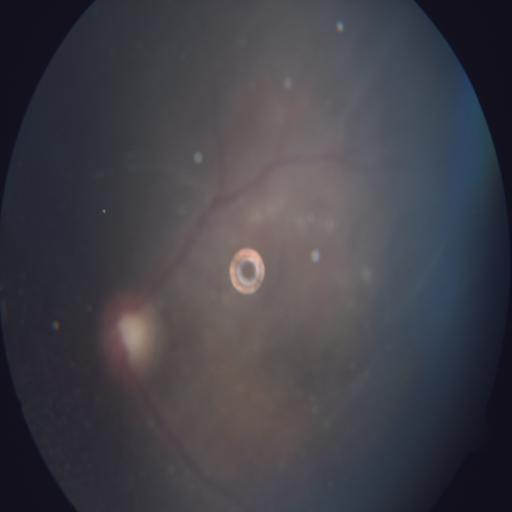 Retinal fundus photograph demonstrating media haze (MH).